Fundus photo · FOV: 45 degrees · image size 2352x1568:
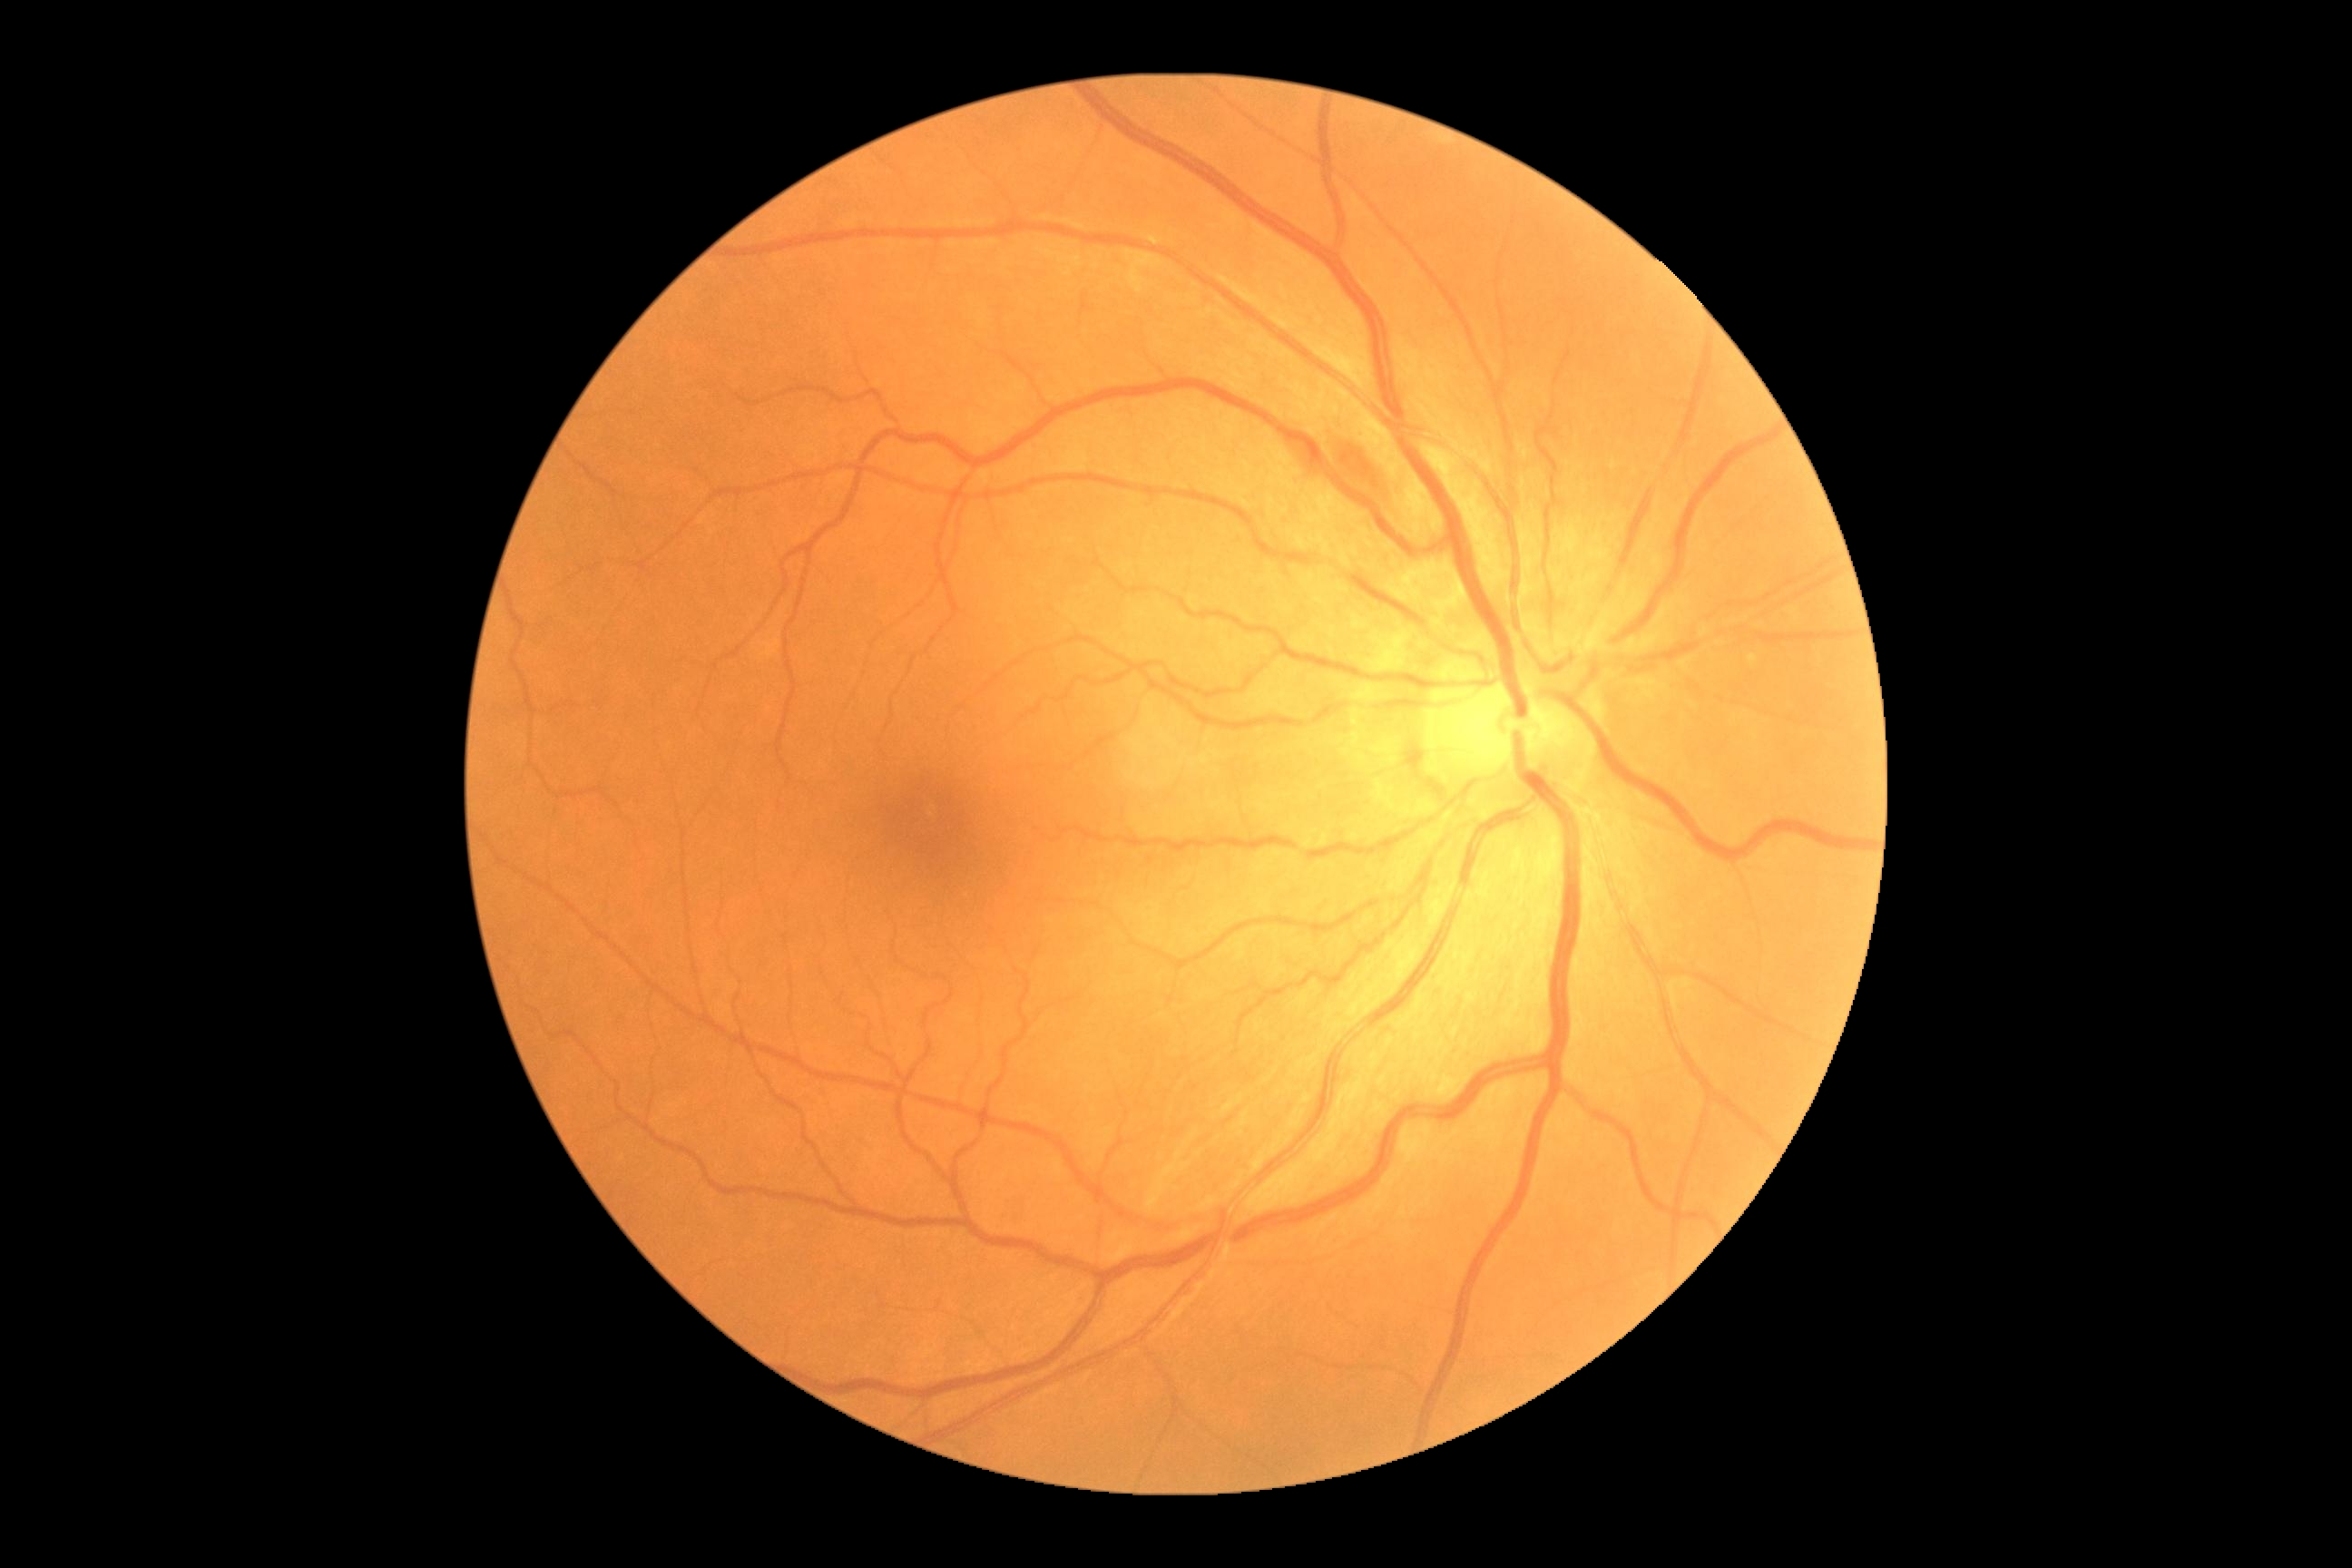

DR class@non-proliferative diabetic retinopathy; DR severity@grade 2.